Color fundus photograph centered on the optic disc; mydriatic:
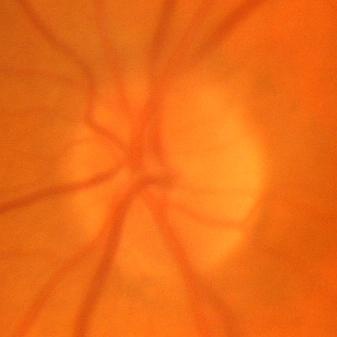

No glaucomatous damage.